Age 68 · refraction: sphere +2 D, cylinder -2 D, axis 92°:
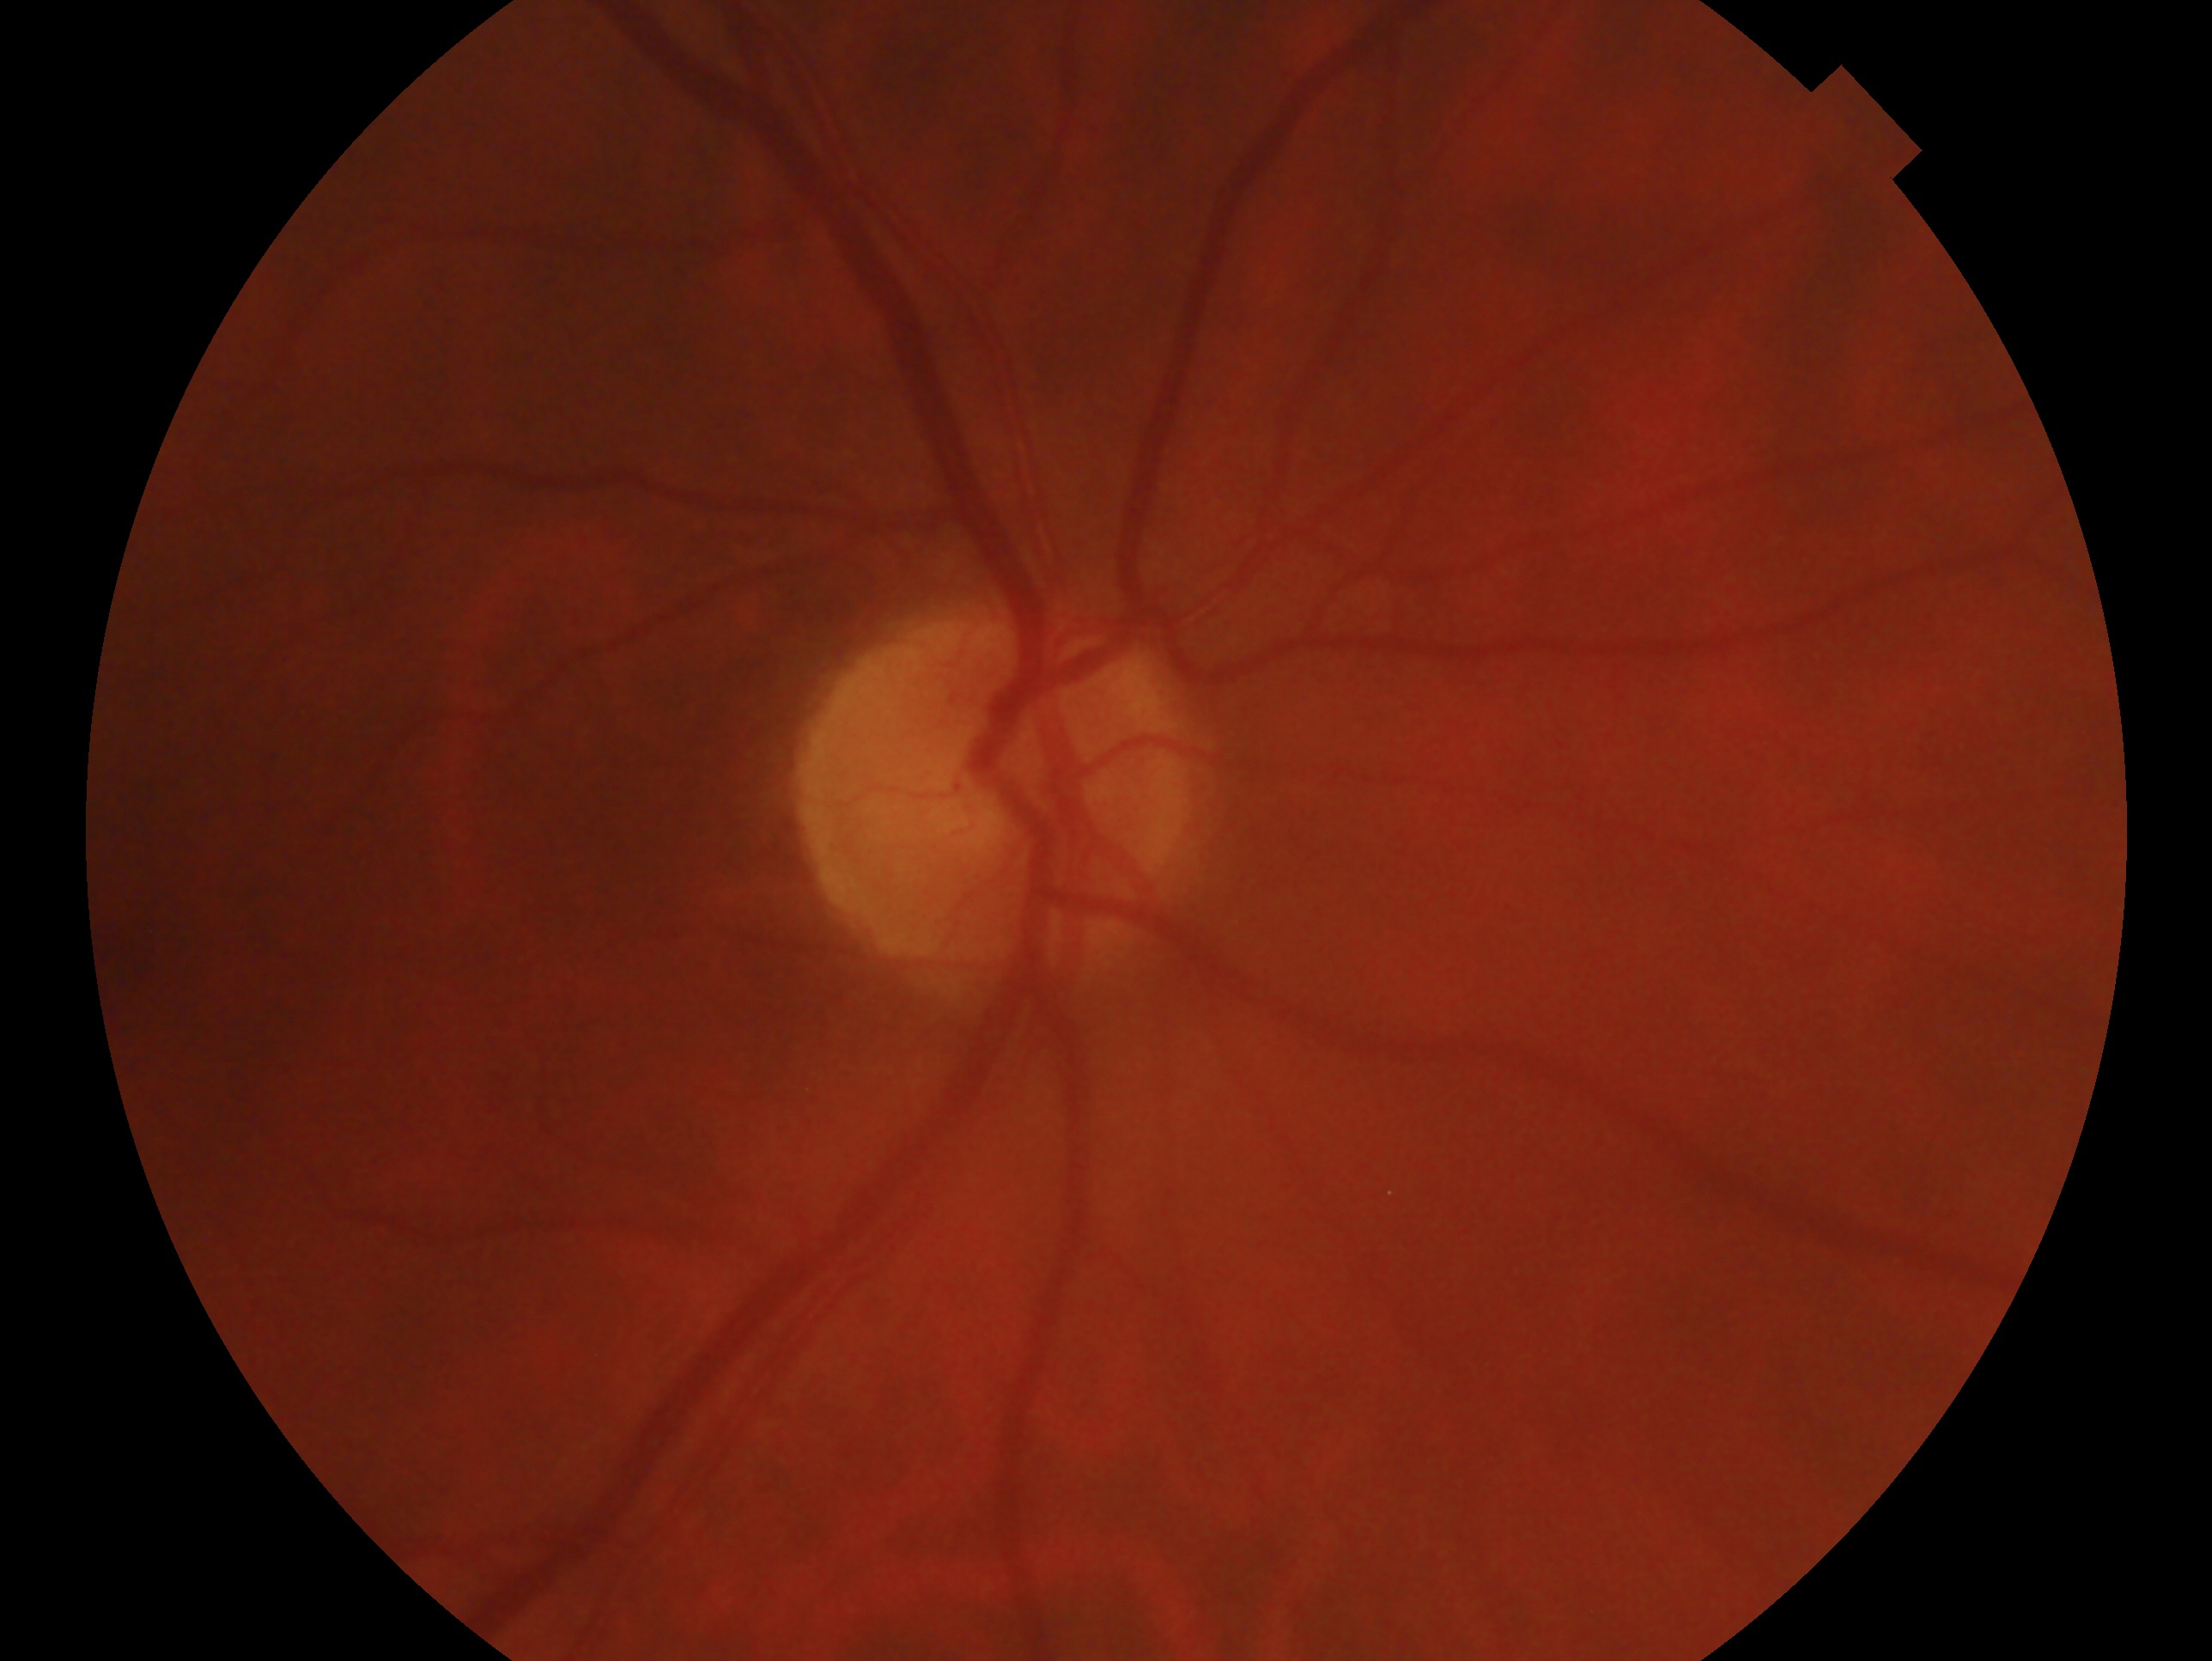 eye: OD; glaucoma assessment: no glaucomatous findings.